240x240. CFP:
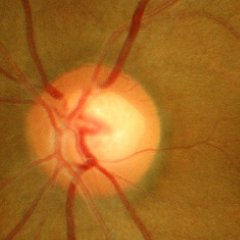
Glaucoma stage: no glaucomatous changes.